Graded on the modified Davis scale: 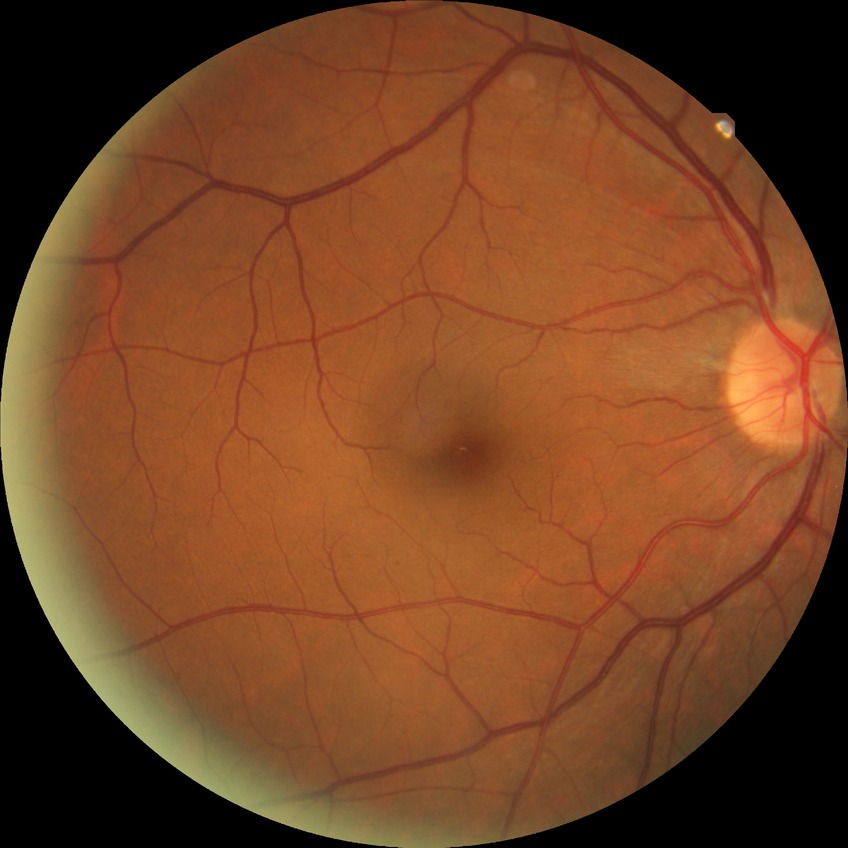 {
  "davis_grade": "SDR (simple diabetic retinopathy)",
  "proliferative_class": "non-proliferative diabetic retinopathy"
}